Retinal fundus photograph, no pharmacologic dilation.
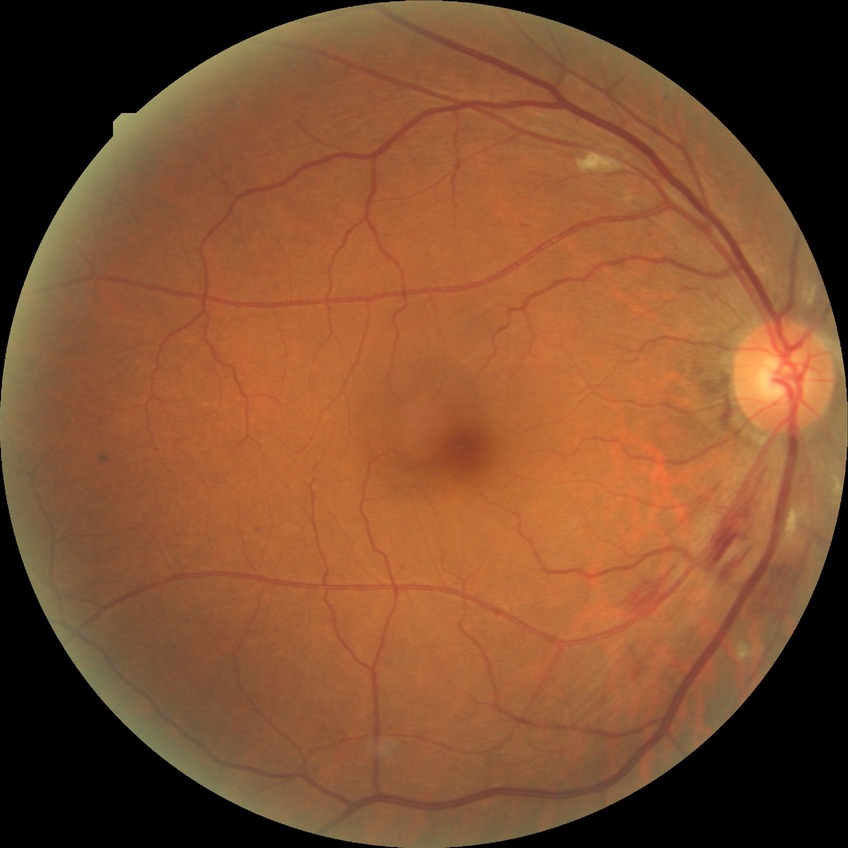
Davis stage is PPDR.